Wide-field fundus photograph of an infant. Acquired on the Clarity RetCam 3:
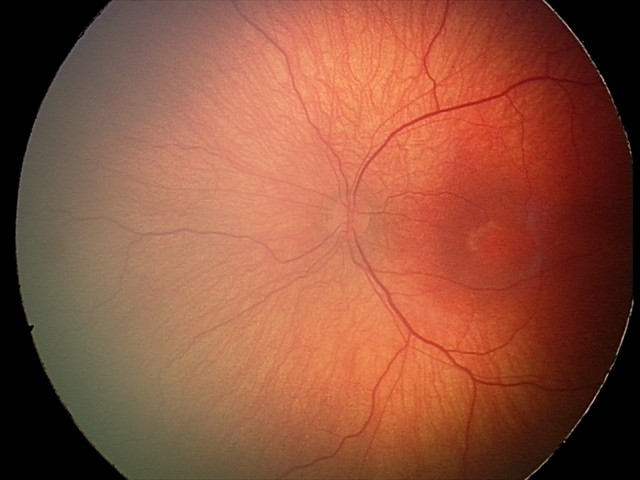

Retinopathy of prematurity (ROP) stage: 1; plus disease: absent.